Phoenix ICON, 100° FOV · infant wide-field retinal image:
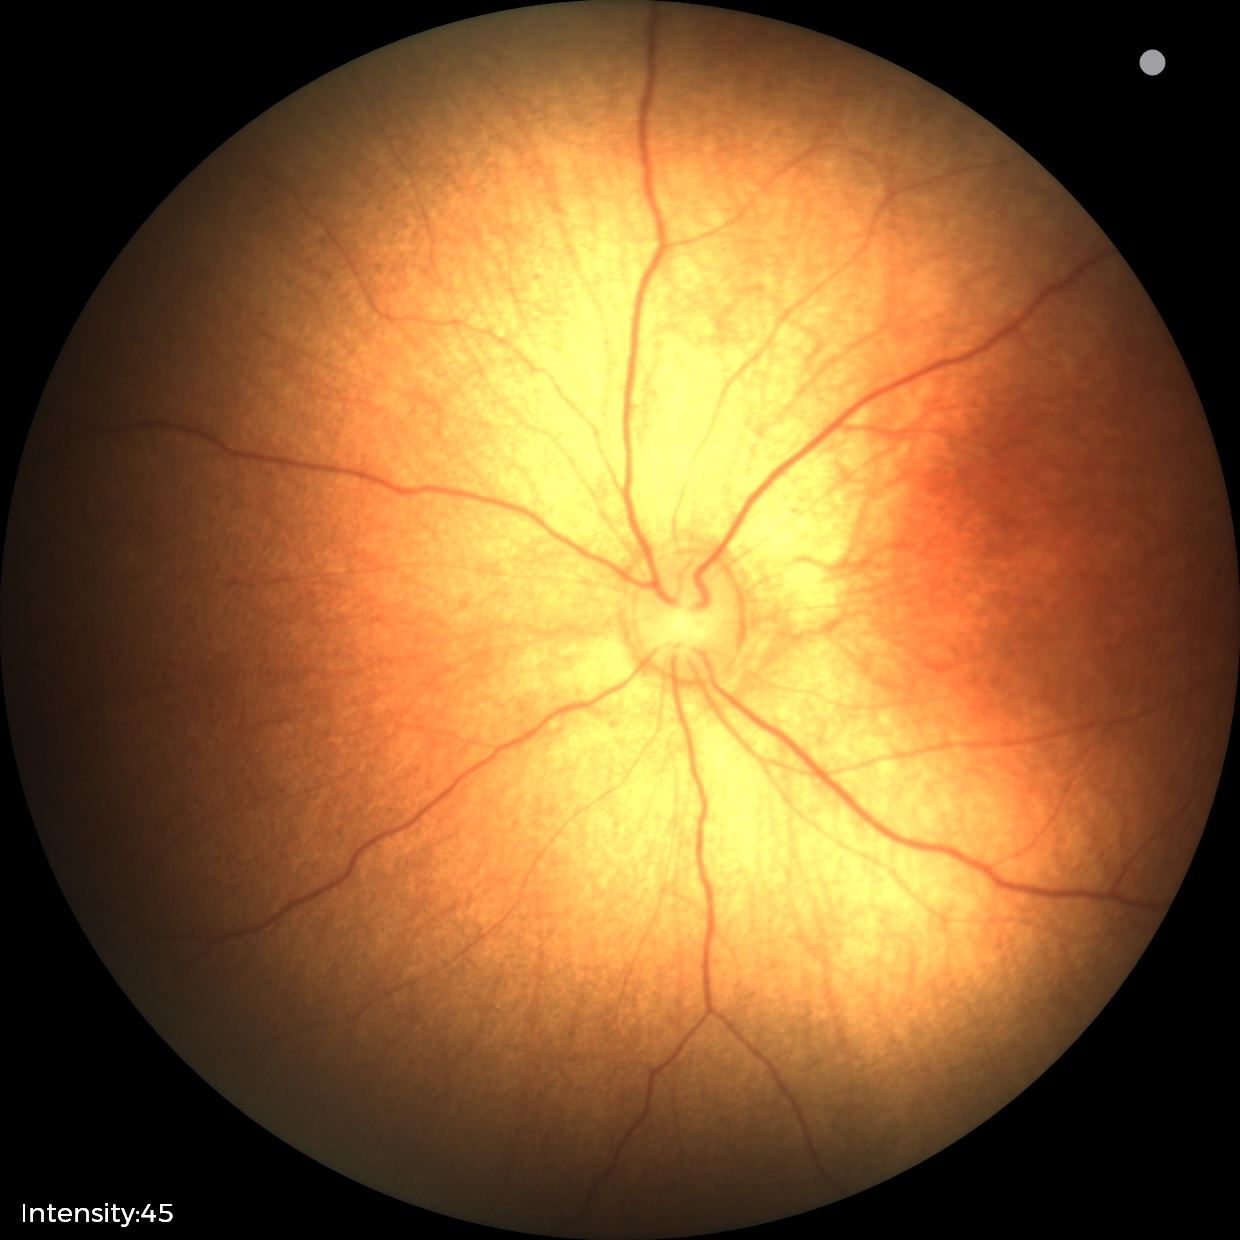
Impression: physiological retinal finding.